Nonmydriatic; acquired with a NIDEK AFC-230.
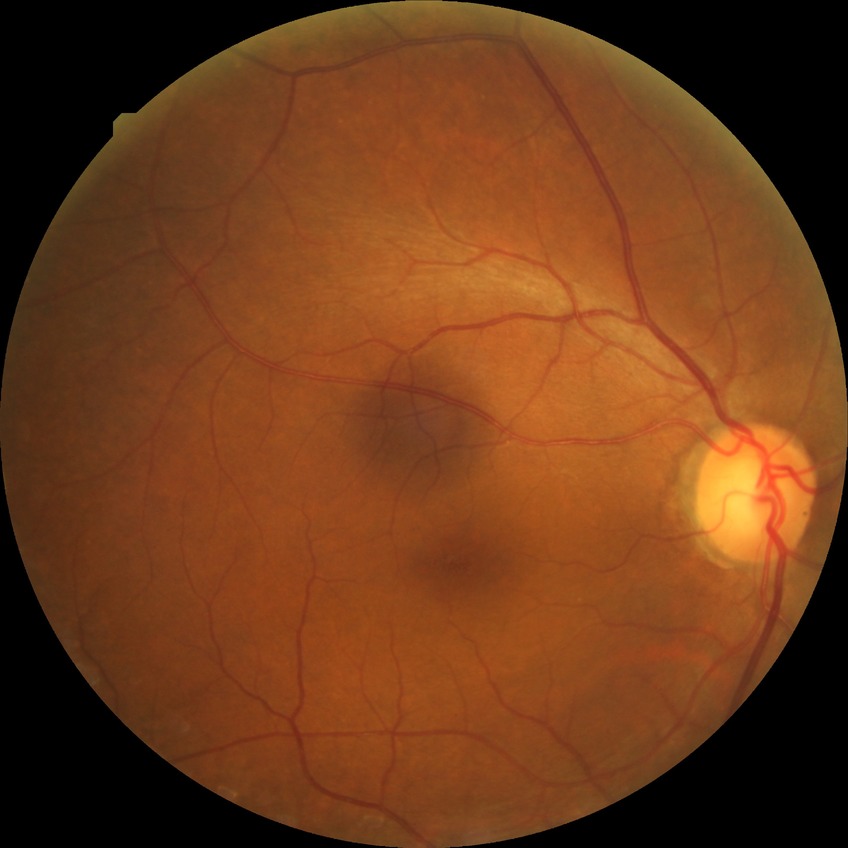

Modified Davis classification: simple diabetic retinopathy.